Ultra-widefield fundus mosaic — 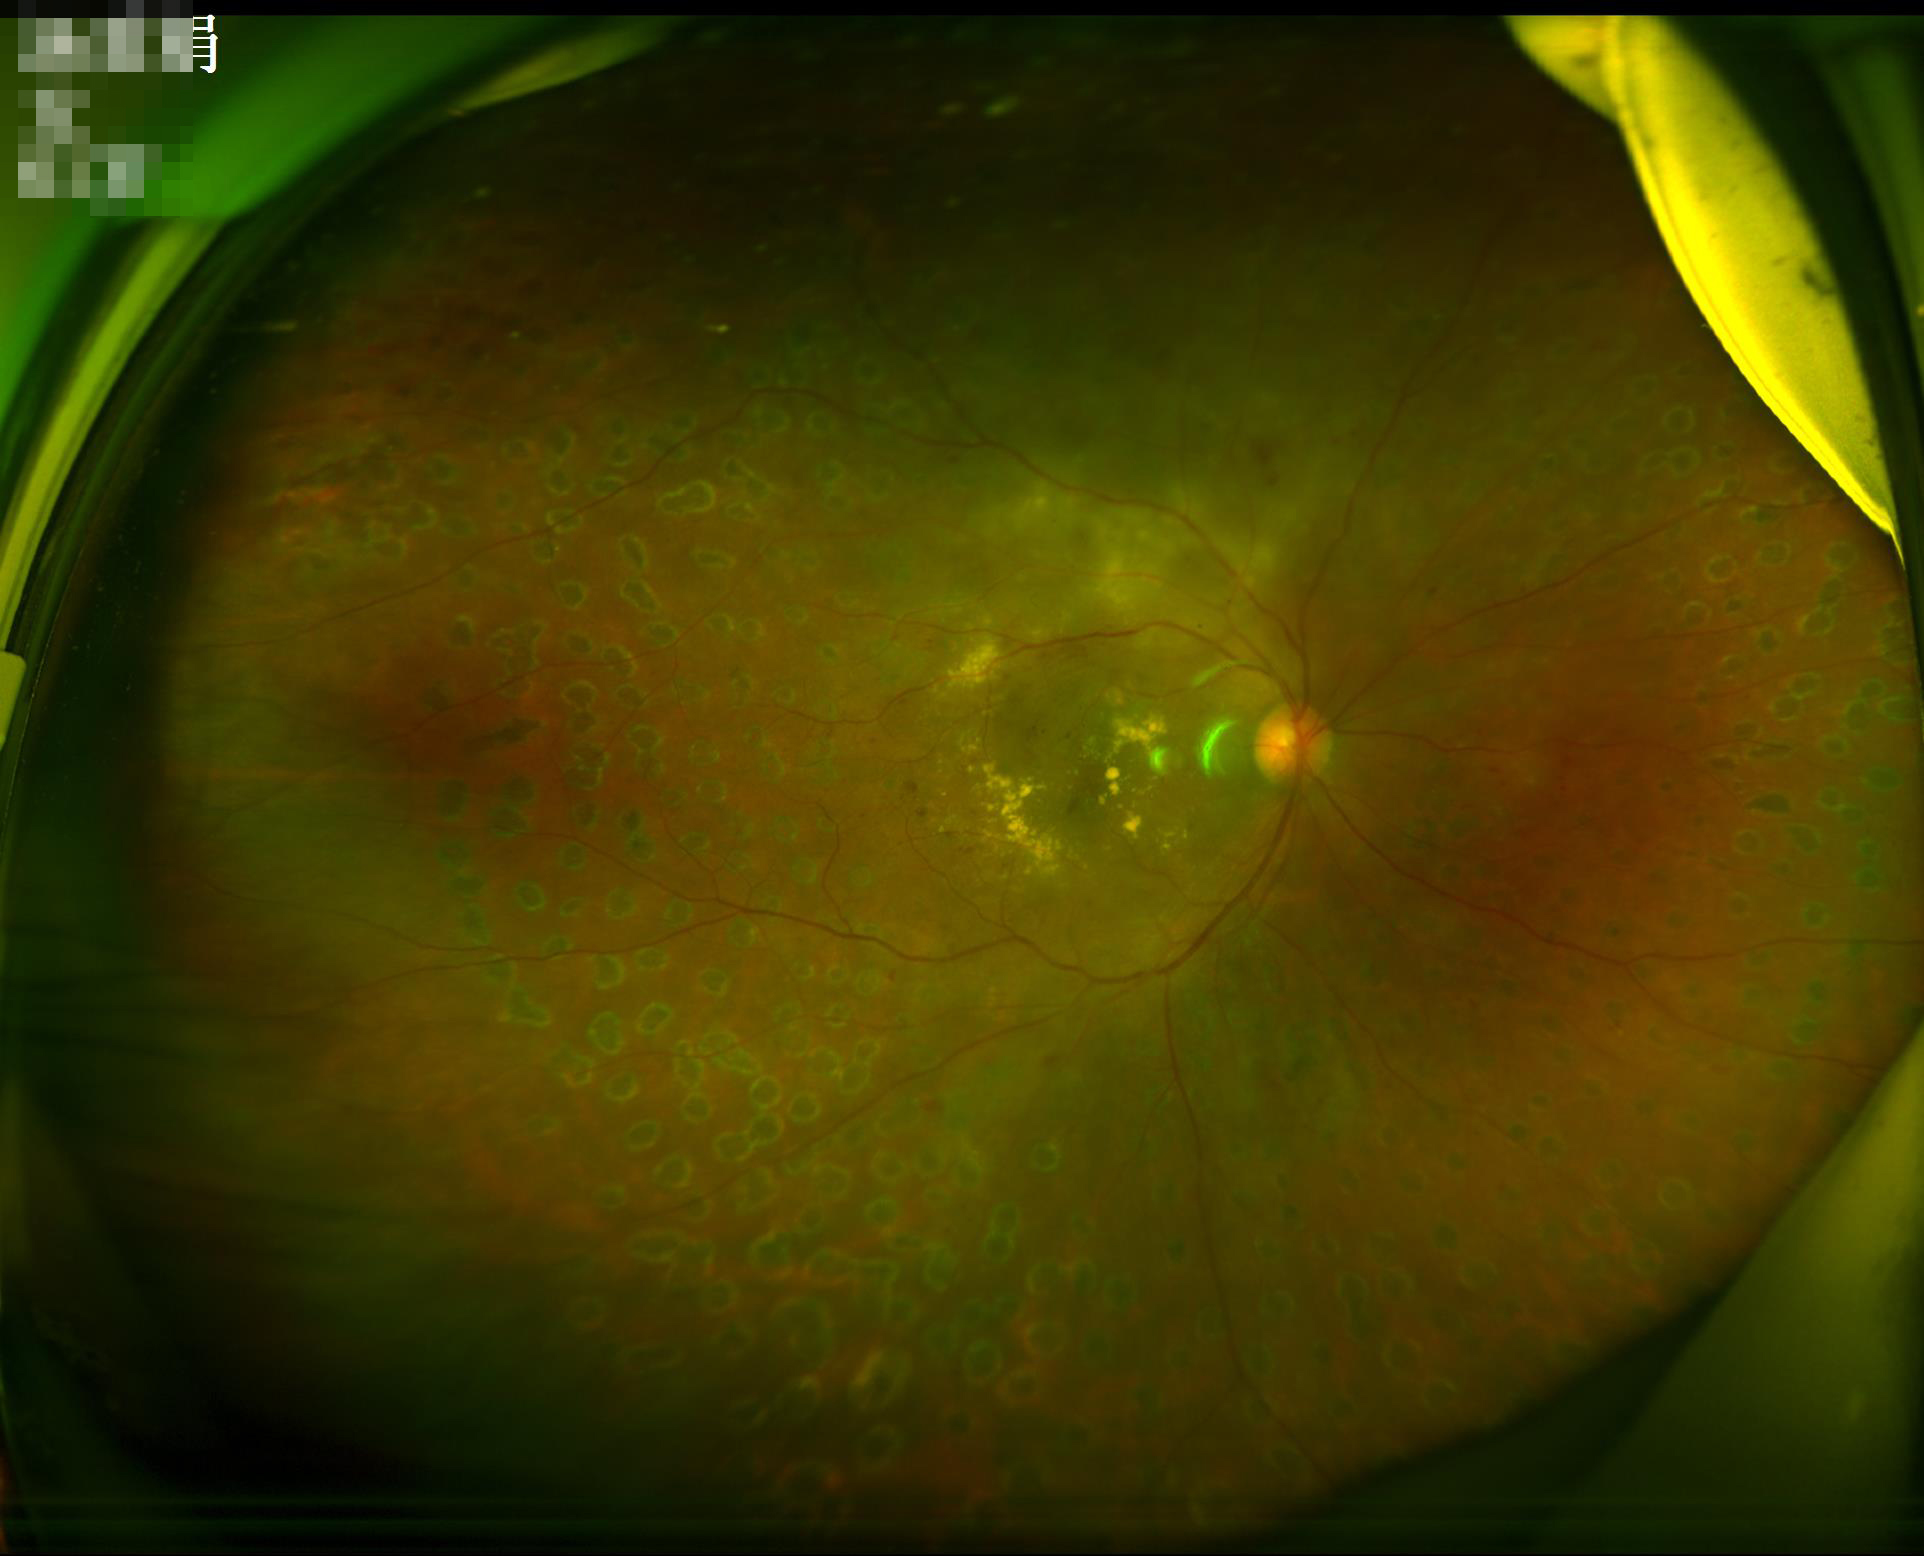
Vessels and details are readily distinguishable.